Wide-field fundus photograph from neonatal ROP screening · 1240 by 1240 pixels — 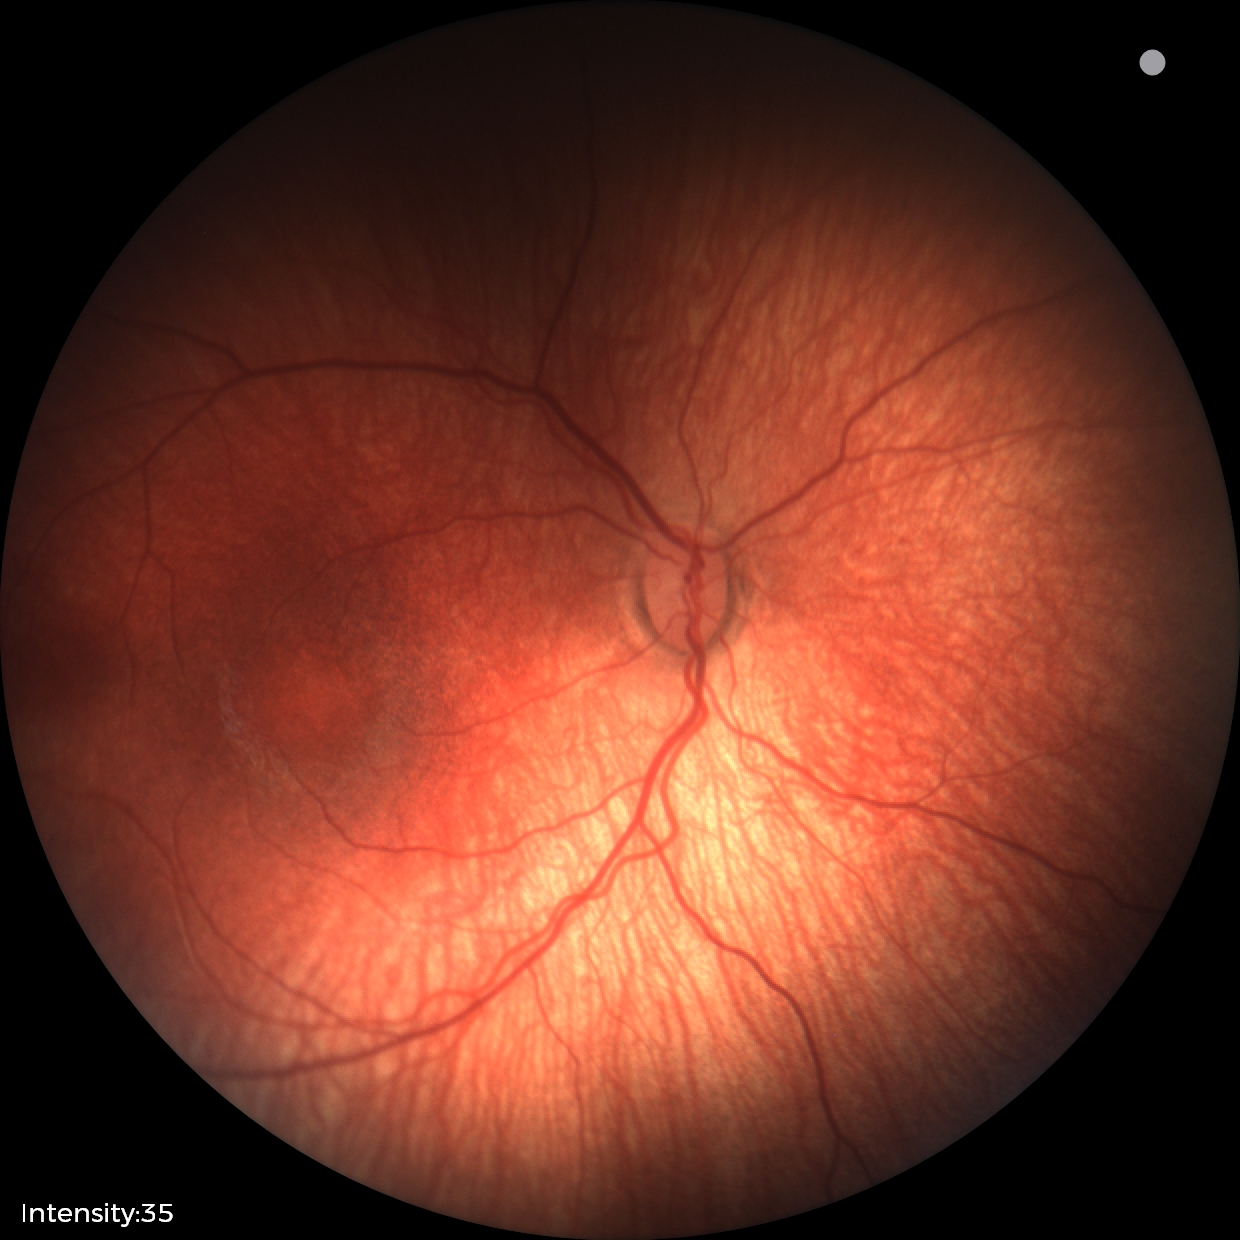 Examination diagnosed as status post retinopathy of prematurity.